Image size 848x848.
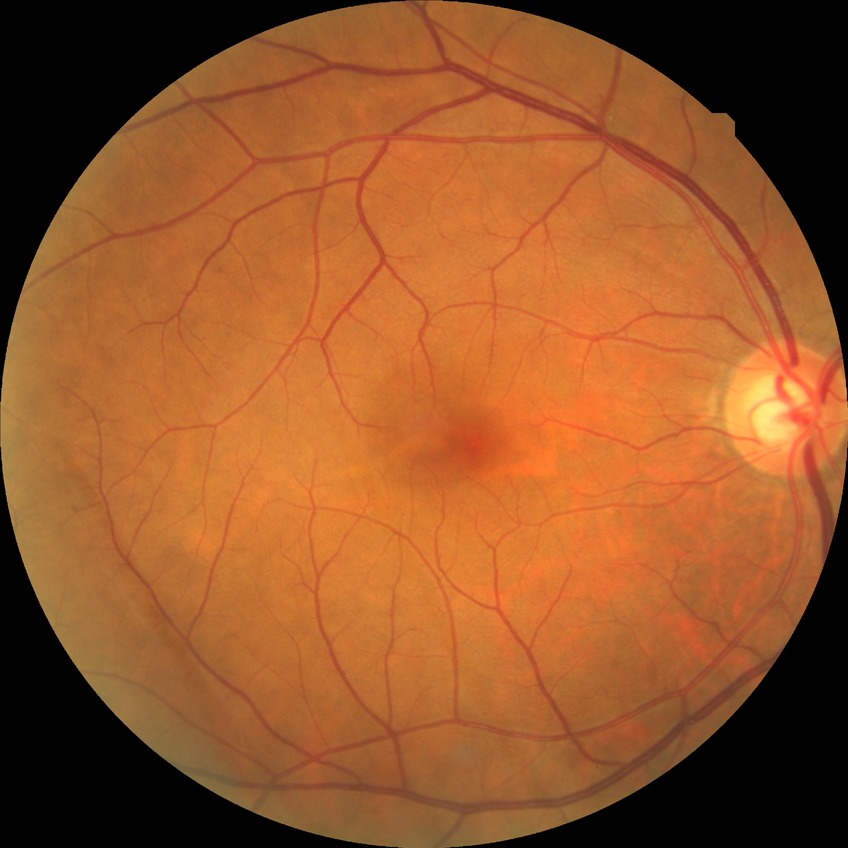 Diabetic retinopathy (DR) is NDR (no diabetic retinopathy).